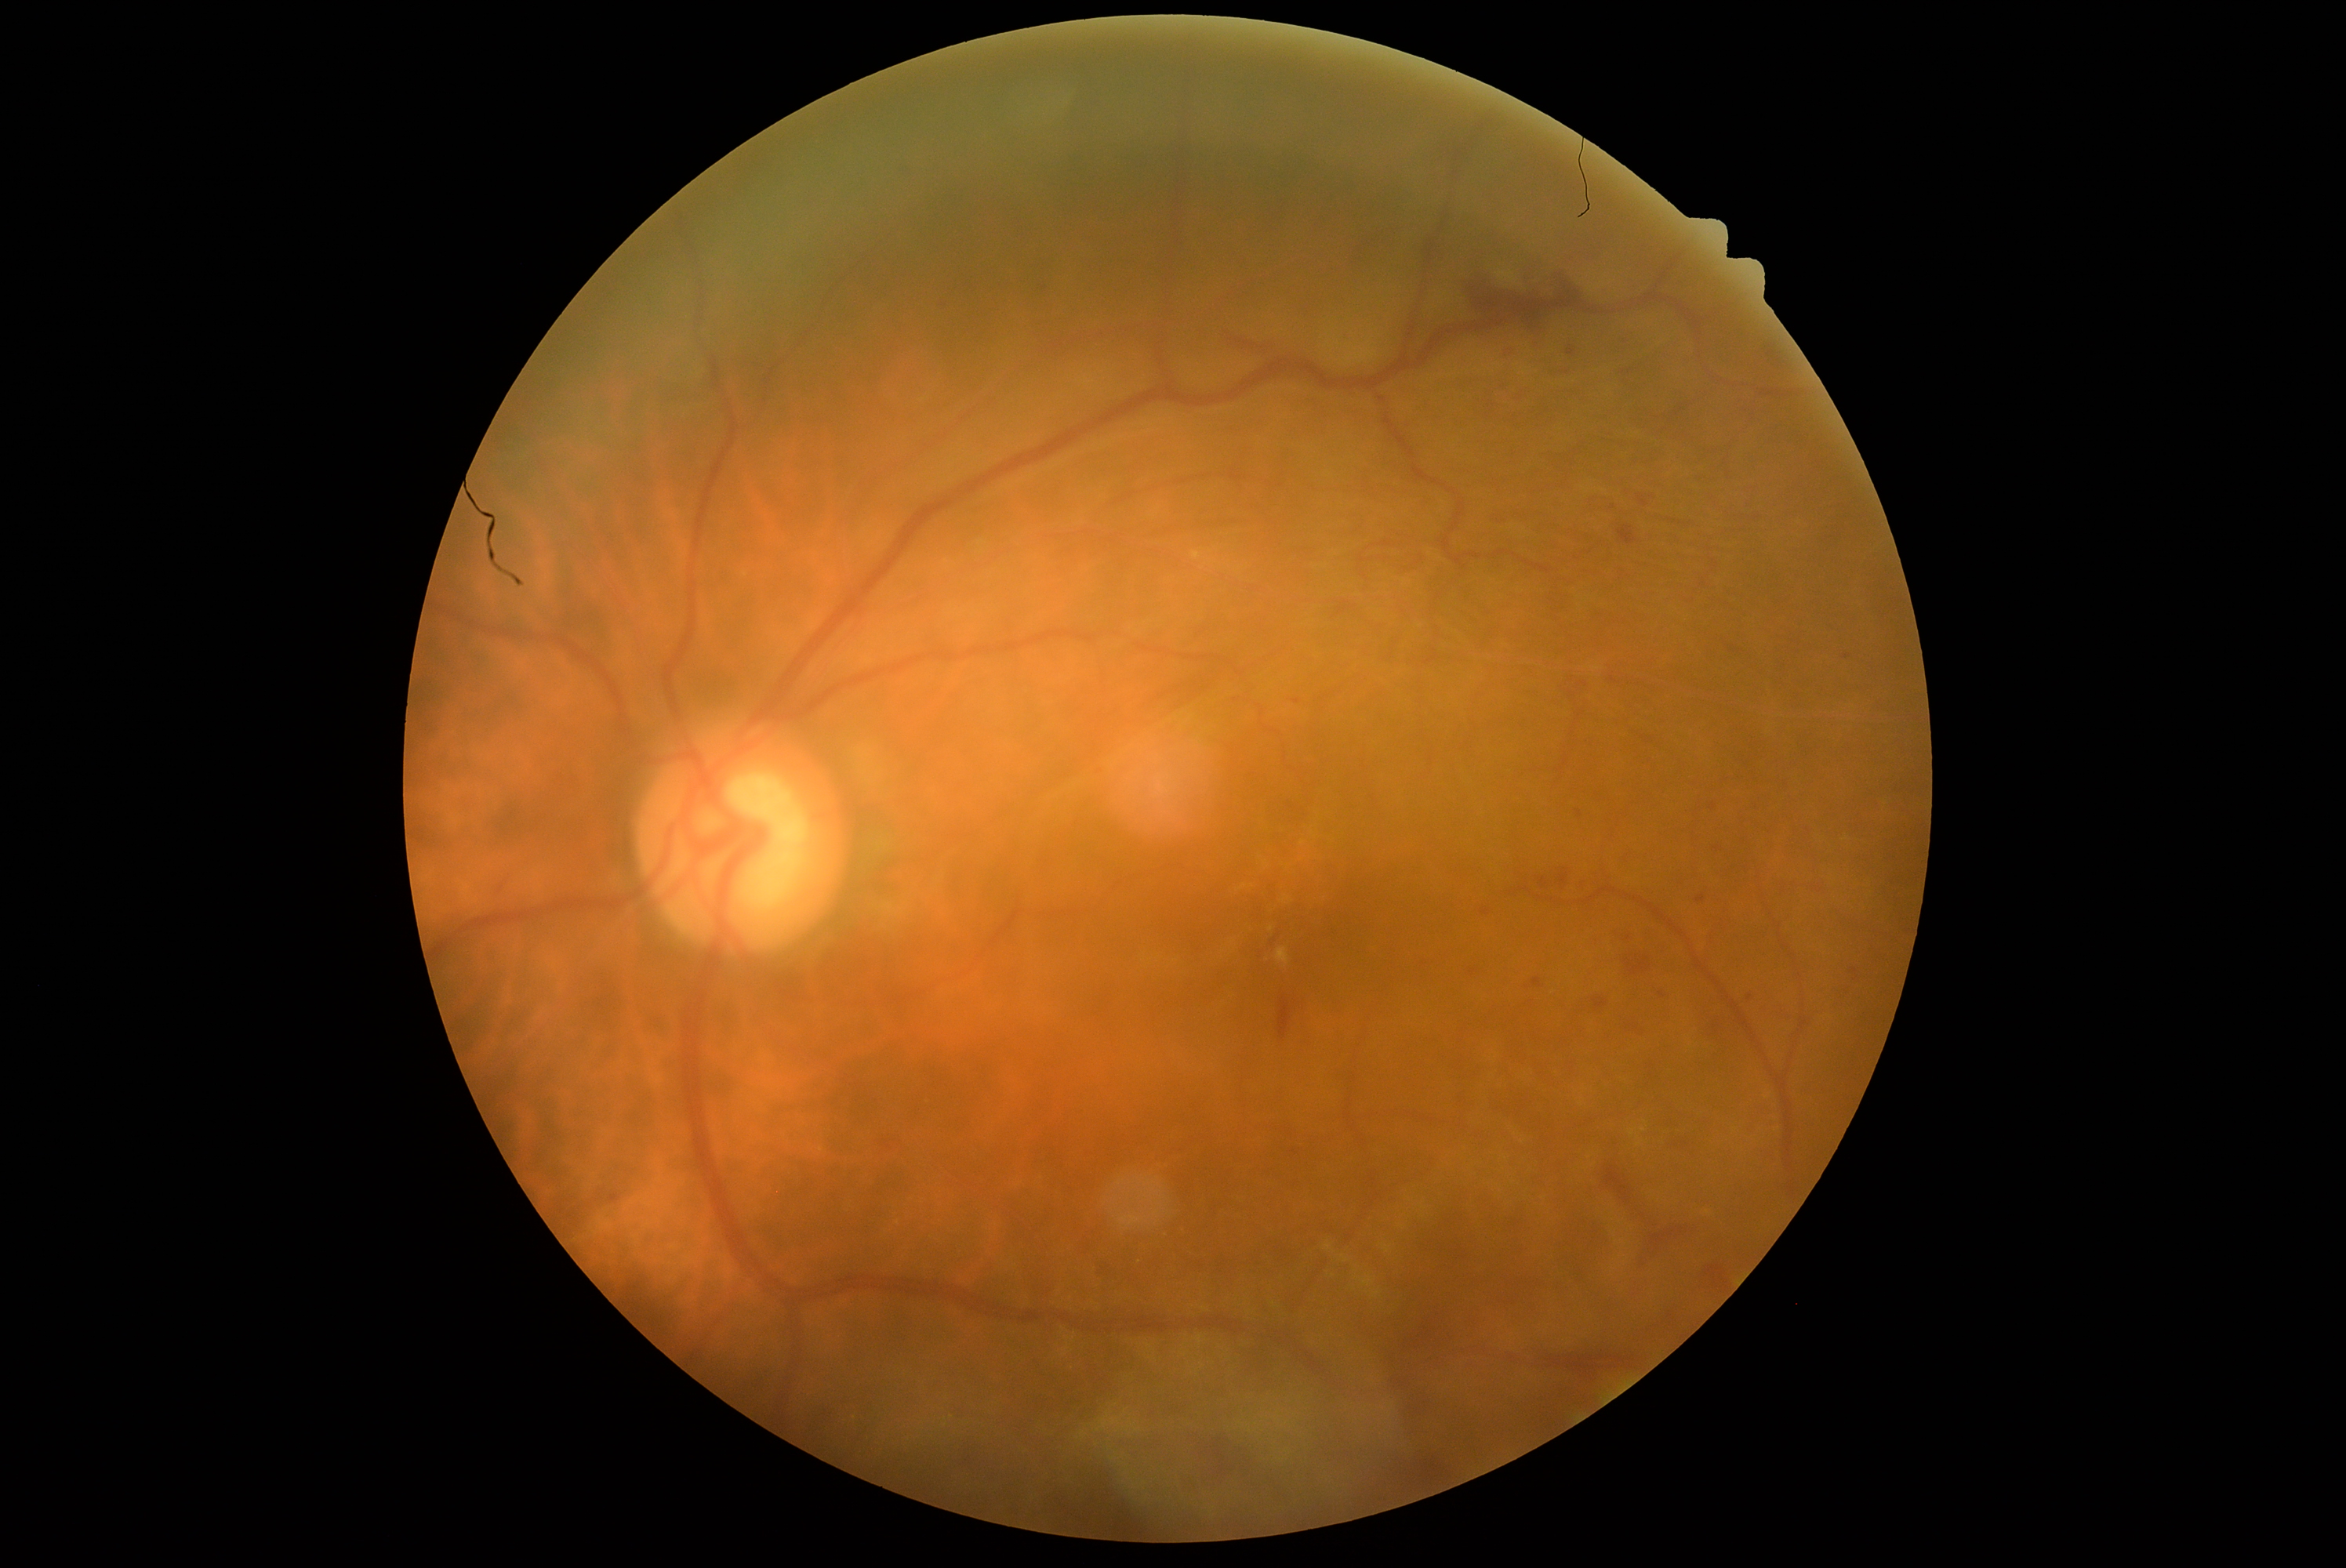 {"partial":true,"dr_grade":2,"lesions":{"ex":[[1277,948,1290,965],[1497,270,1519,285],[1282,896,1290,902],[1193,551,1202,561]],"ex_small":[[1303,843],[1707,1212],[1244,888],[1272,929]],"he":[[1771,1004,1798,1022],[1533,979,1542,989],[1696,895,1705,902],[871,1131,907,1158],[1491,514,1514,528],[1456,266,1599,350],[1740,482,1765,510],[1616,336,1636,350],[1560,869,1569,887],[1614,524,1641,545],[1541,586,1582,619],[1619,1020,1652,1039]],"he_small":[[1714,807],[1855,972]],"ma":null,"se":null}}